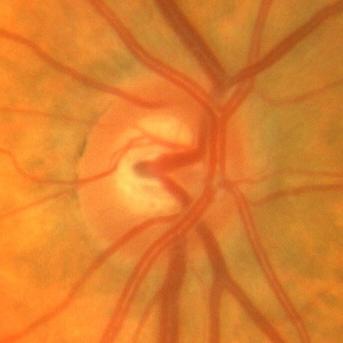 Q: What is the glaucoma diagnosis?
A: No — no glaucomatous optic neuropathy.